640 by 480 pixels · pediatric retinal photograph (wide-field)
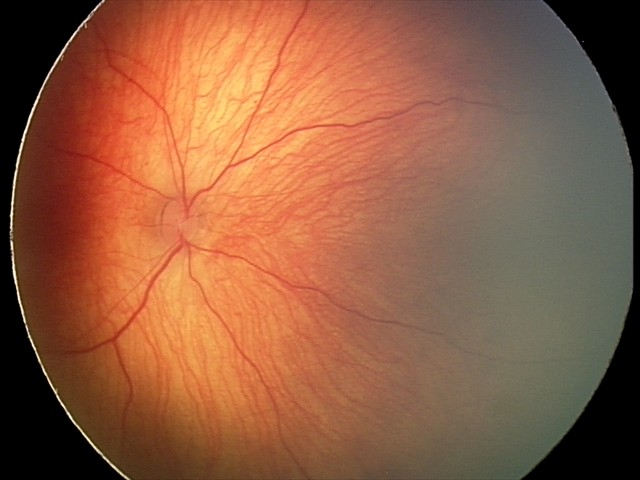 Impression = retinal hemorrhages.